Ultra-widefield (UWF) fundus image:
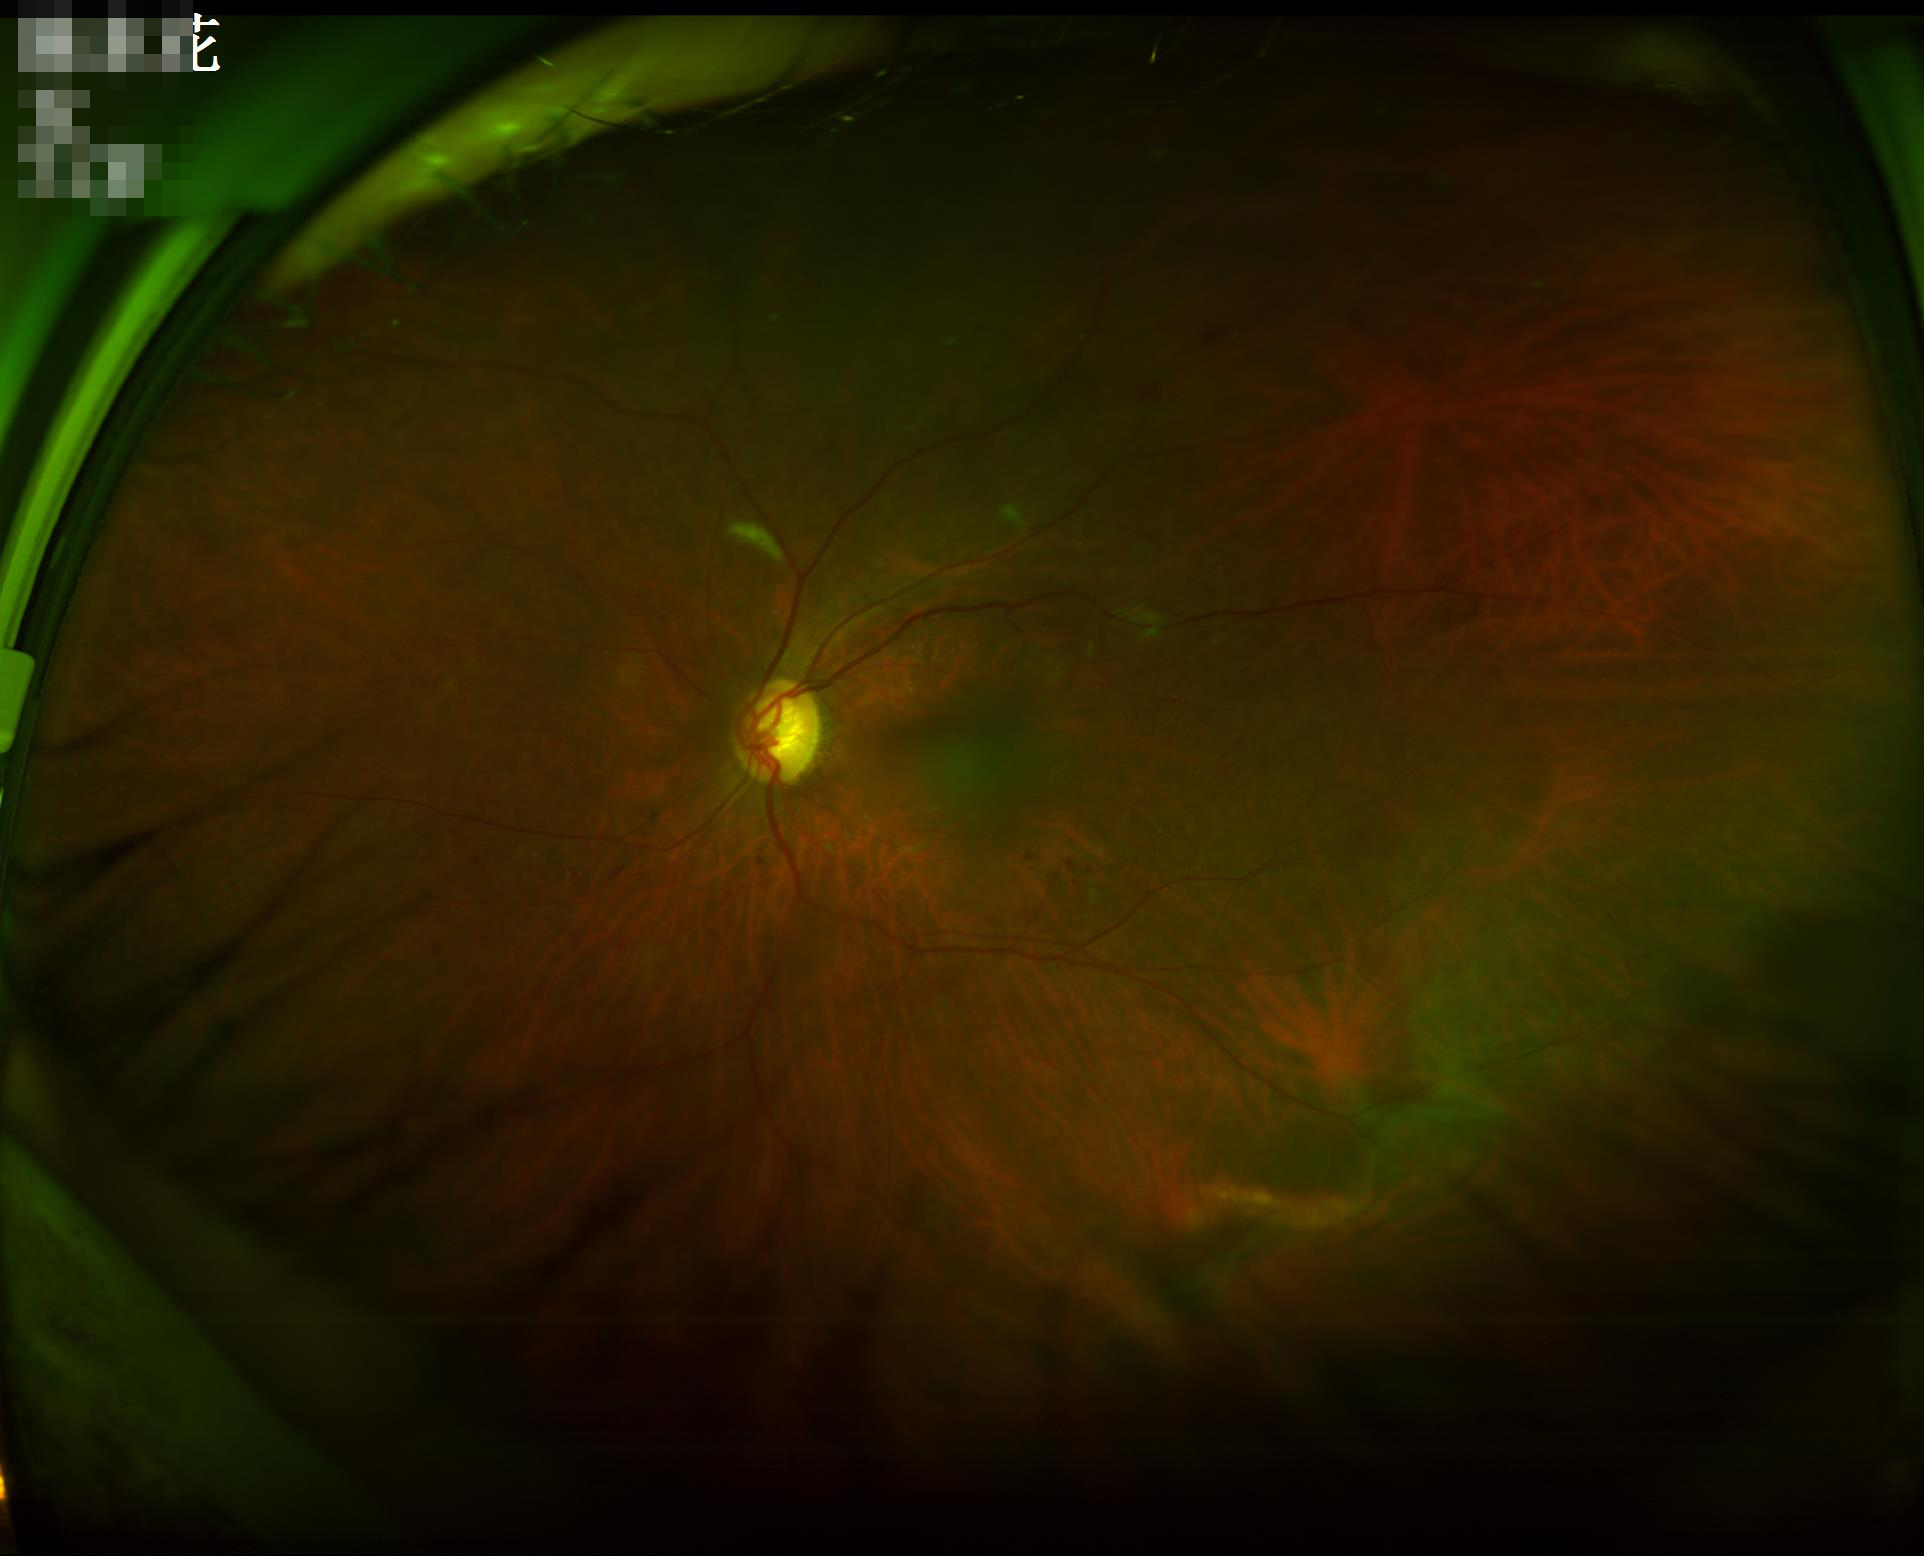

clarity: good
contrast: adequate
illumination: suboptimal
overall_quality: poor